1240 by 1240 pixels · pediatric wide-field fundus photograph.
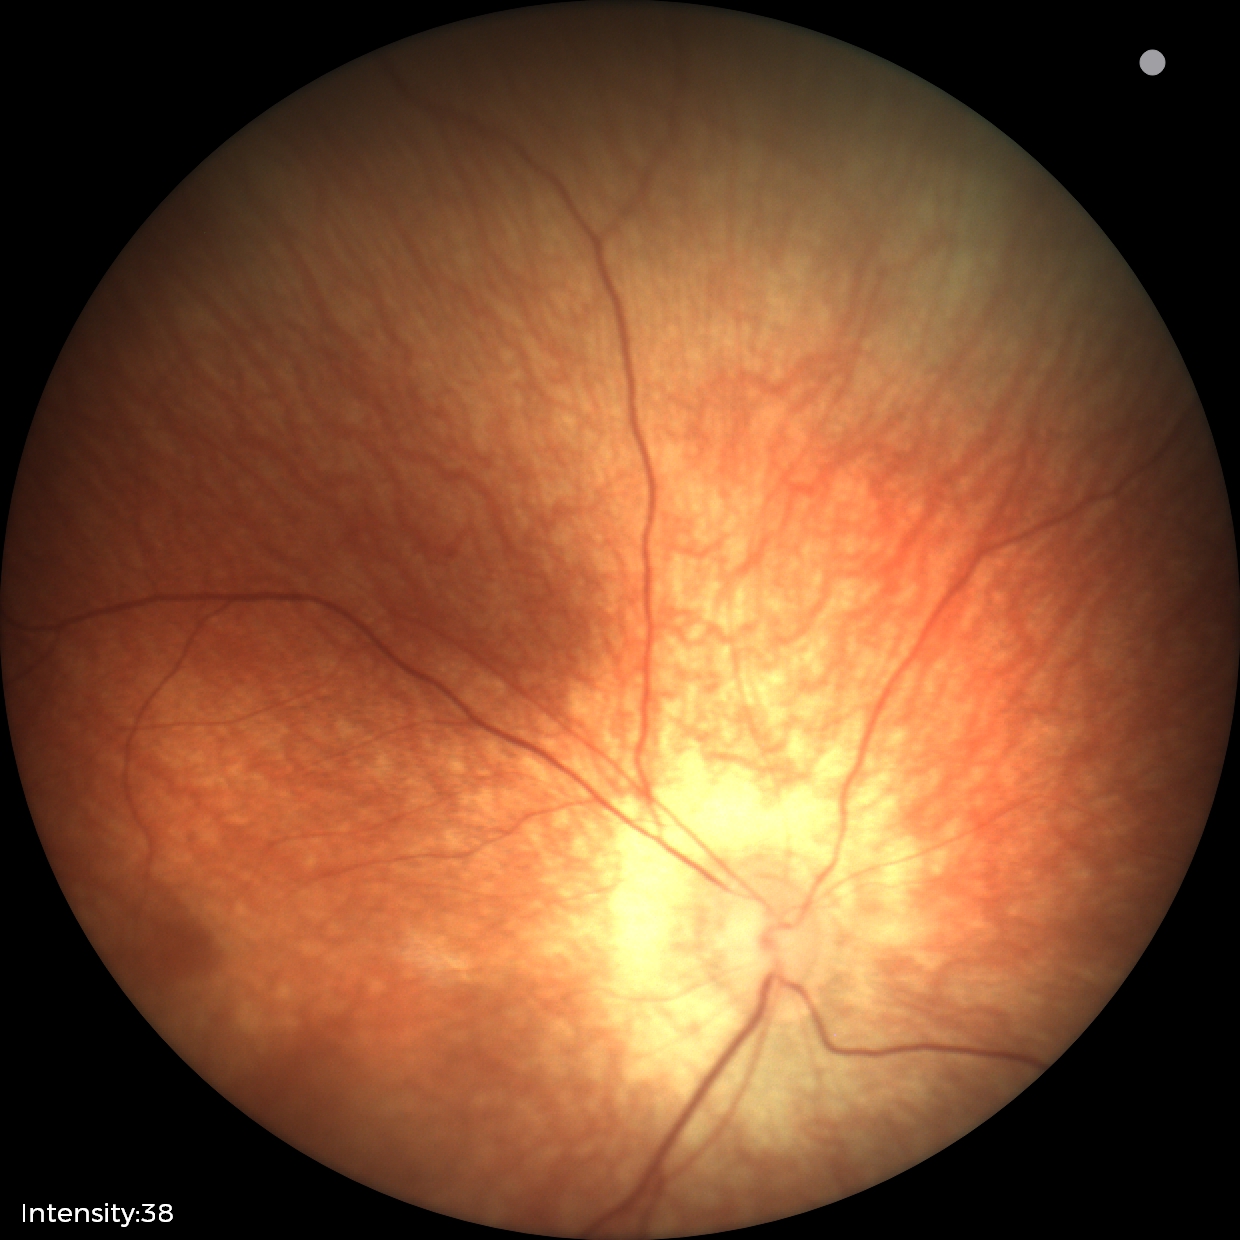
Screening examination with no abnormal retinal findings.